Graded on the modified Davis scale:
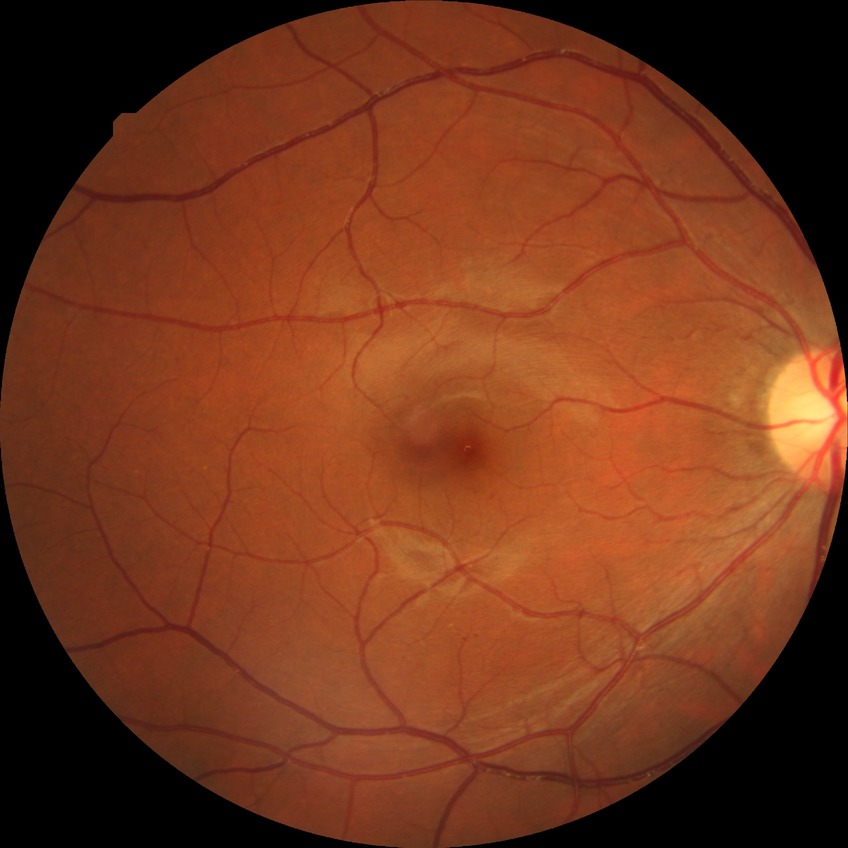 Diabetic retinopathy stage: no diabetic retinopathy.